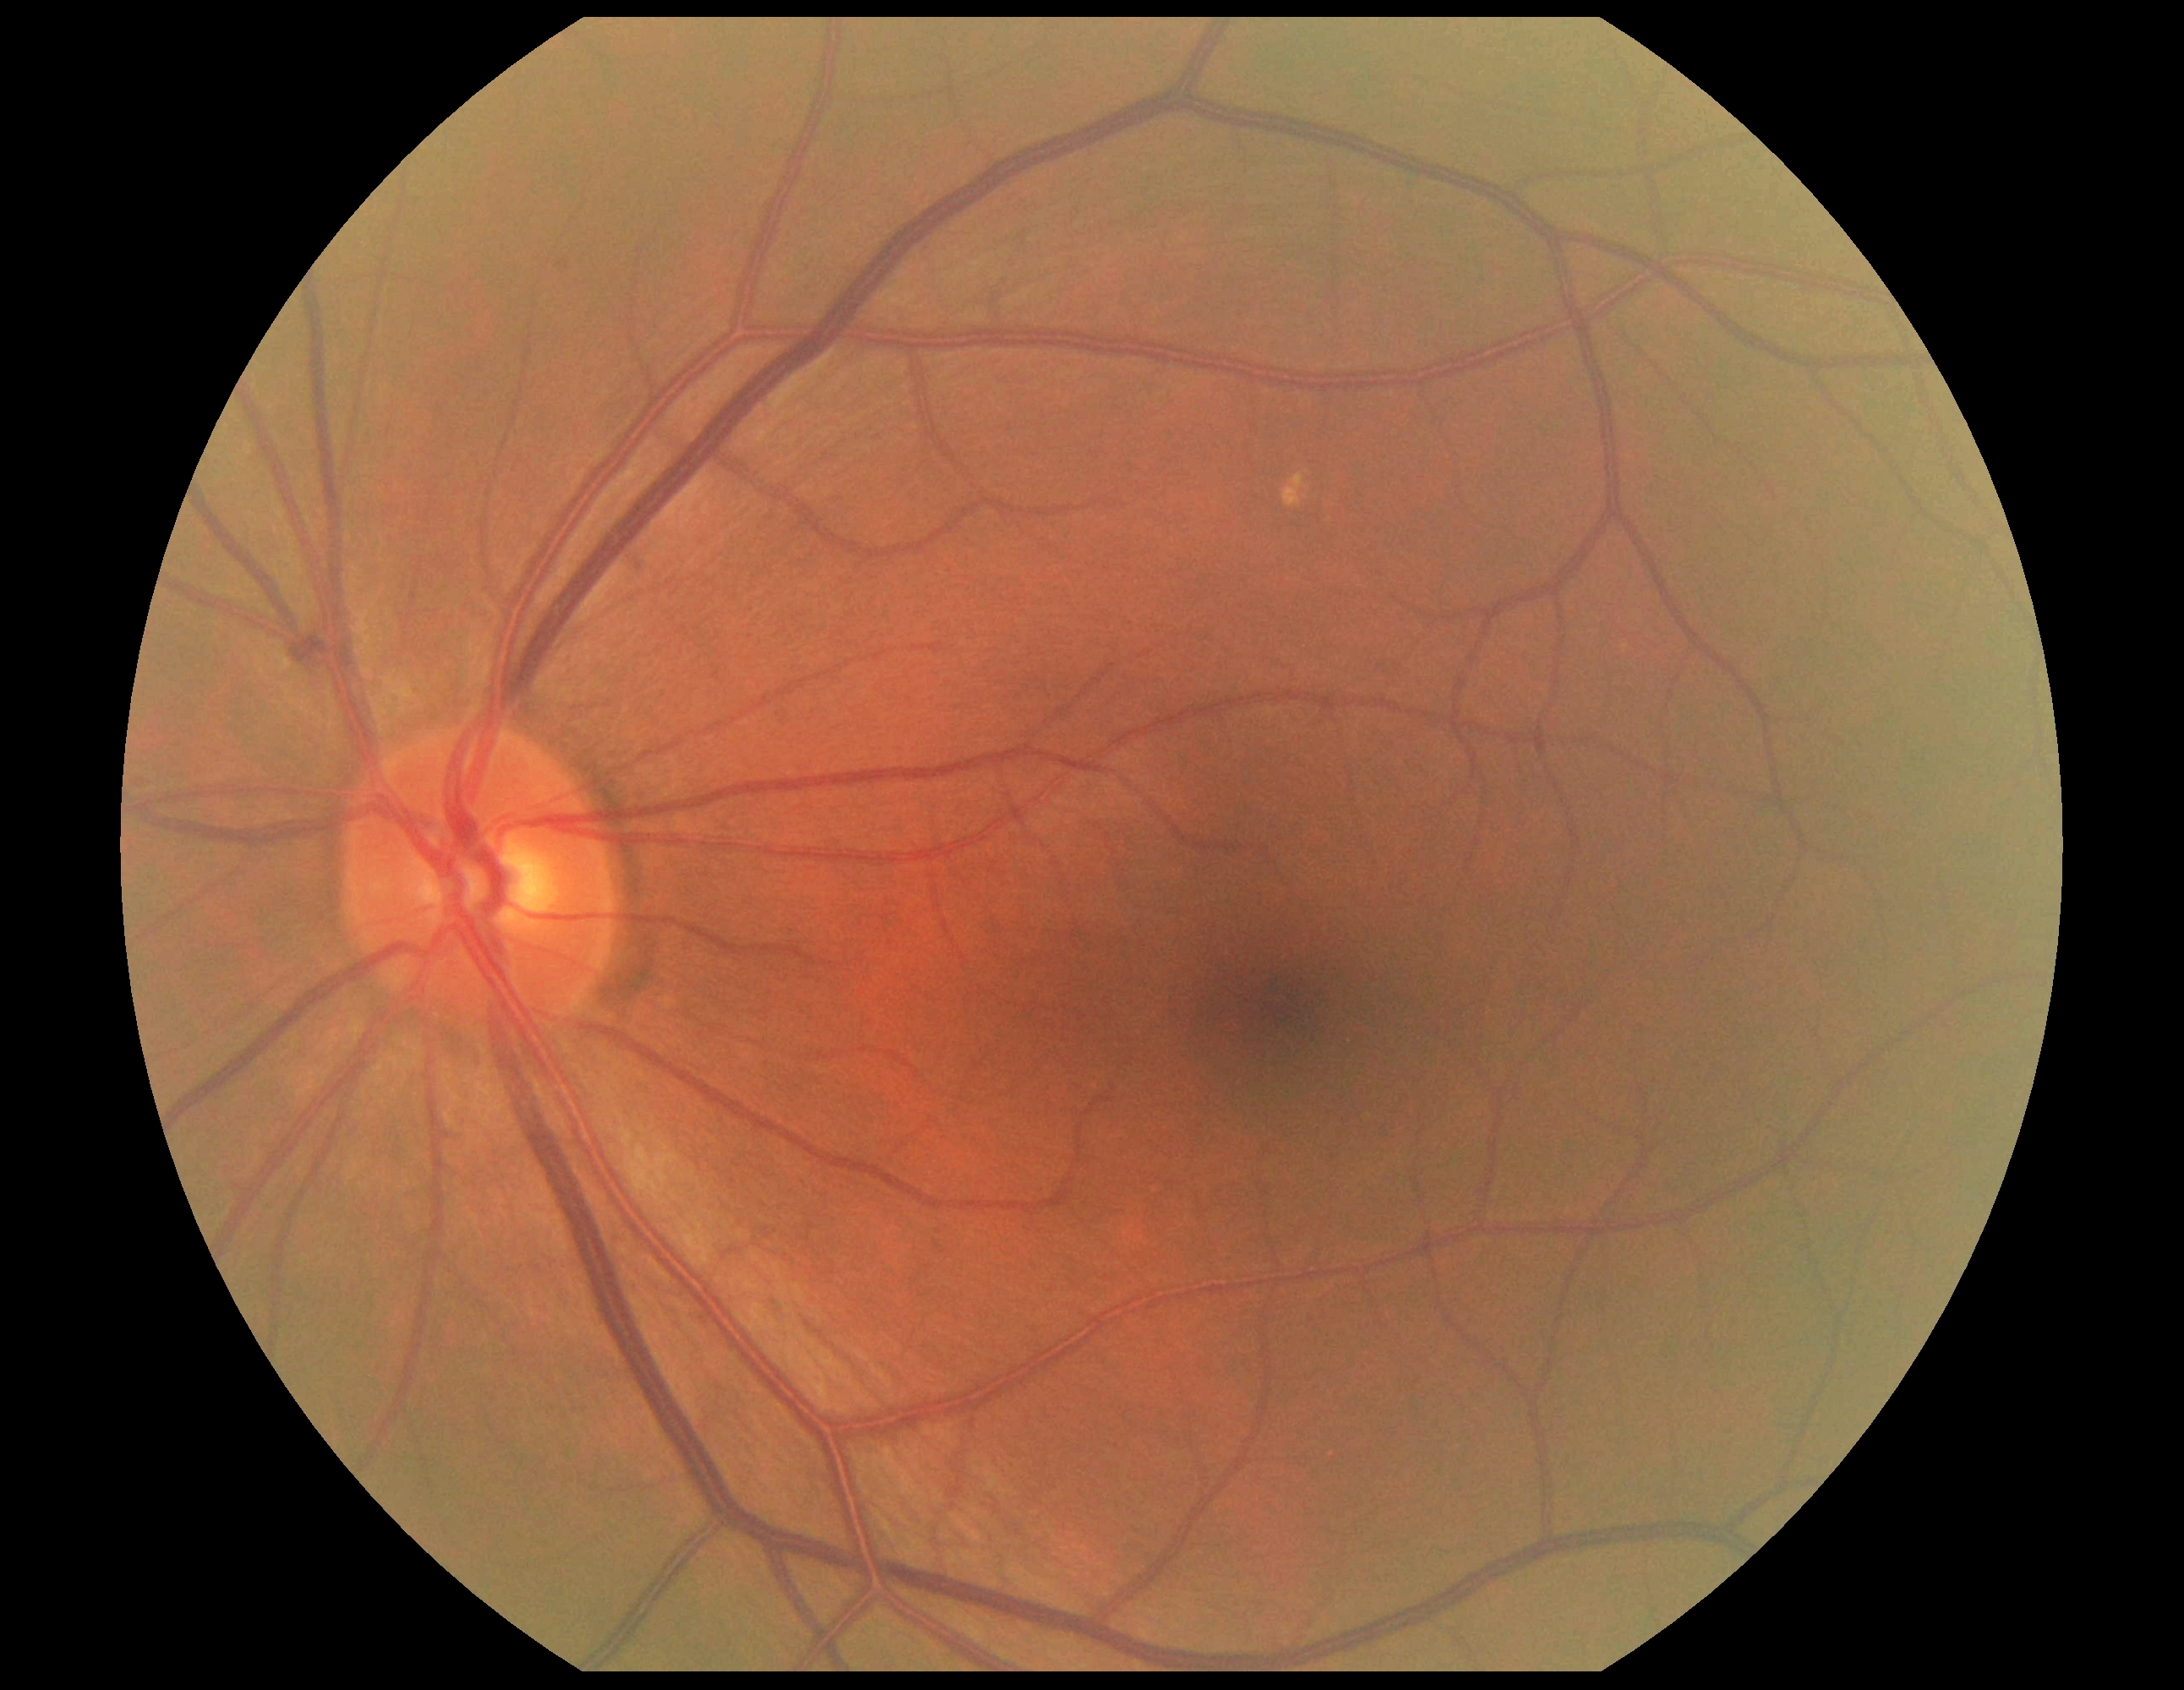 DR stage: no apparent retinopathy (grade 0) — no visible signs of diabetic retinopathy.